1534 by 1534 pixels · 50-degree field of view.
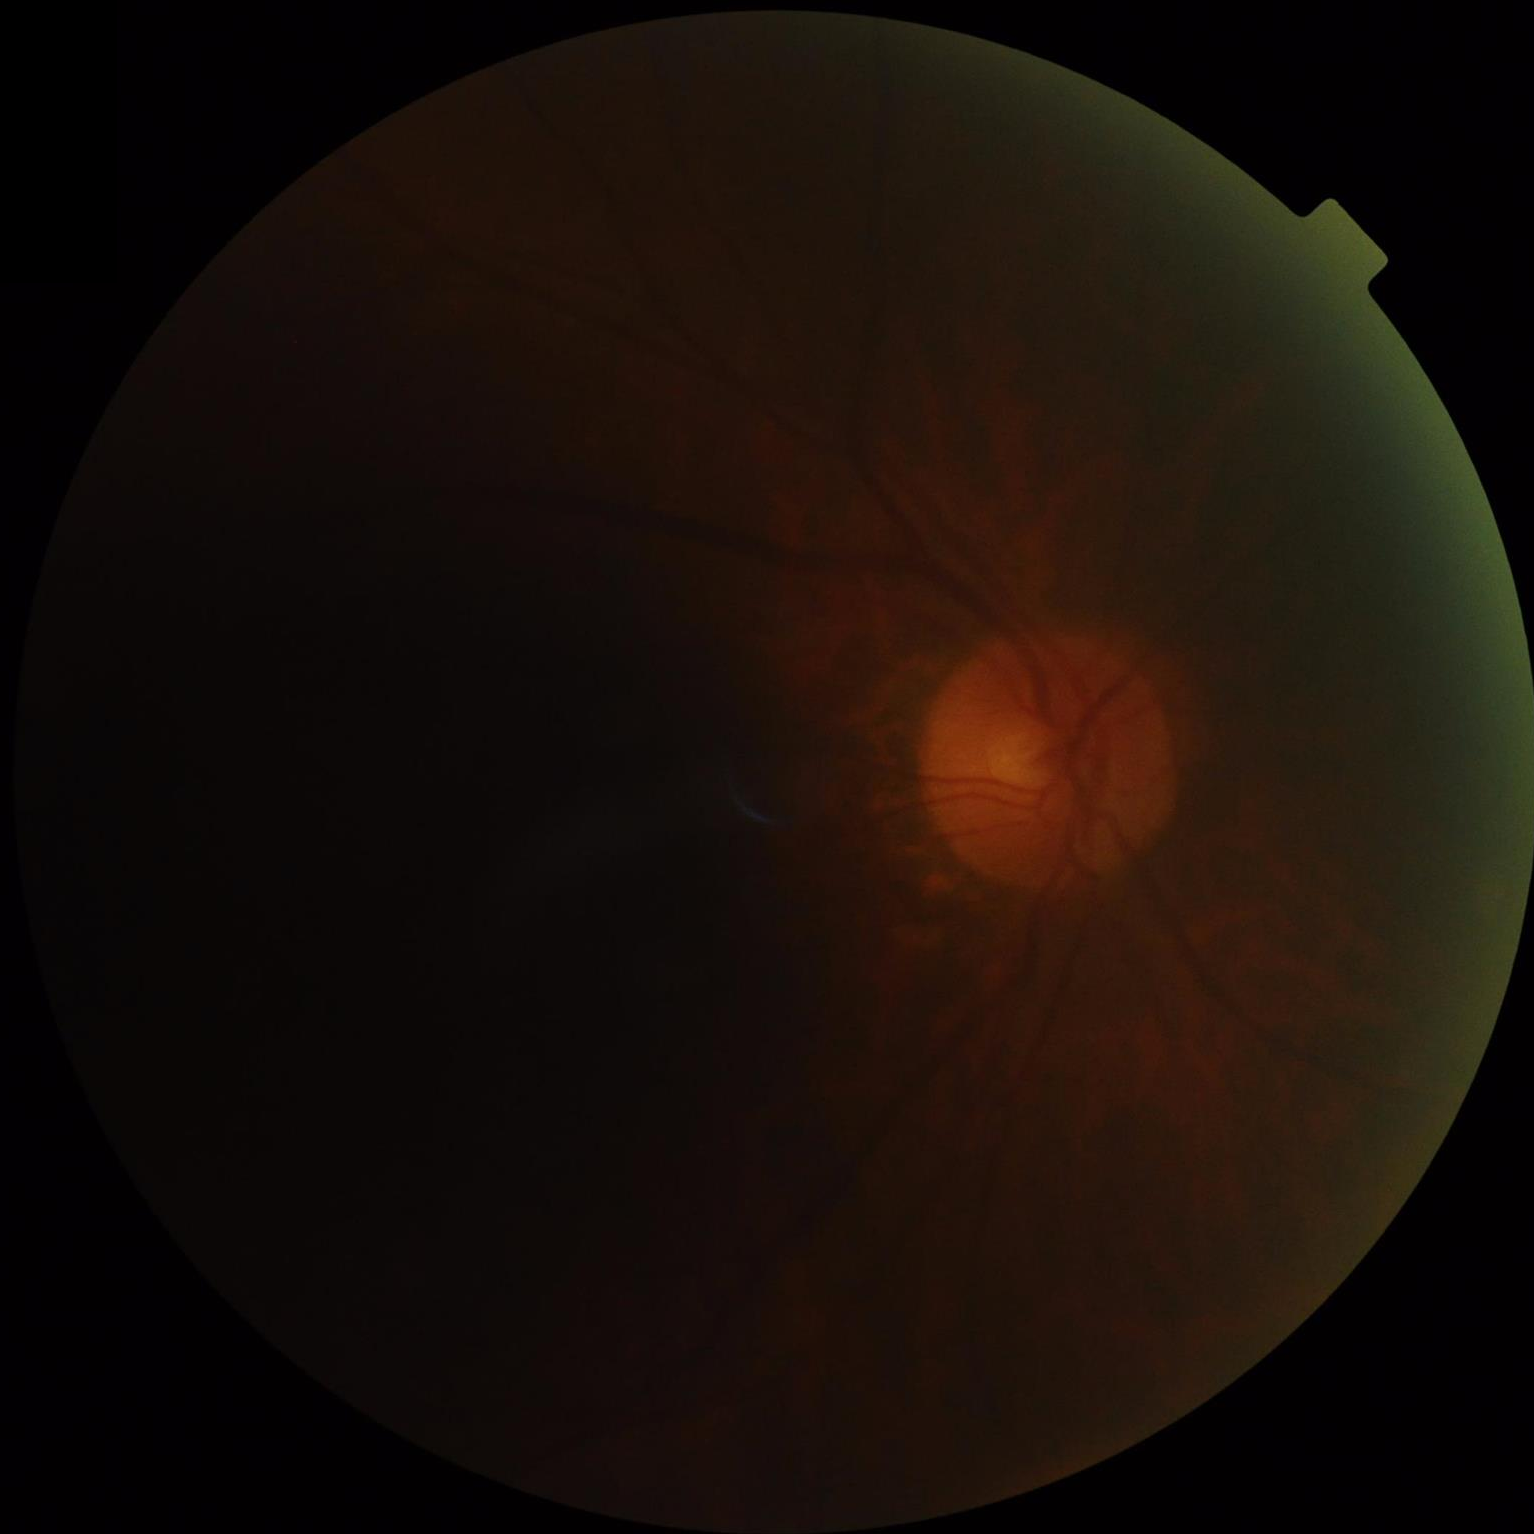
illumination: over- or under-exposed
clarity: noticeable blur in the optic disc, vessels, or background
overall_quality: poor and difficult to use diagnostically
contrast: narrow intensity range, structures hard to distinguish